Retinal fundus photograph
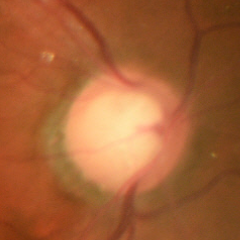 Glaucoma is present. Demonstrates early glaucomatous optic neuropathy.